NIDEK AFC-230 fundus camera · FOV: 45 degrees · no pharmacologic dilation · graded on the modified Davis scale:
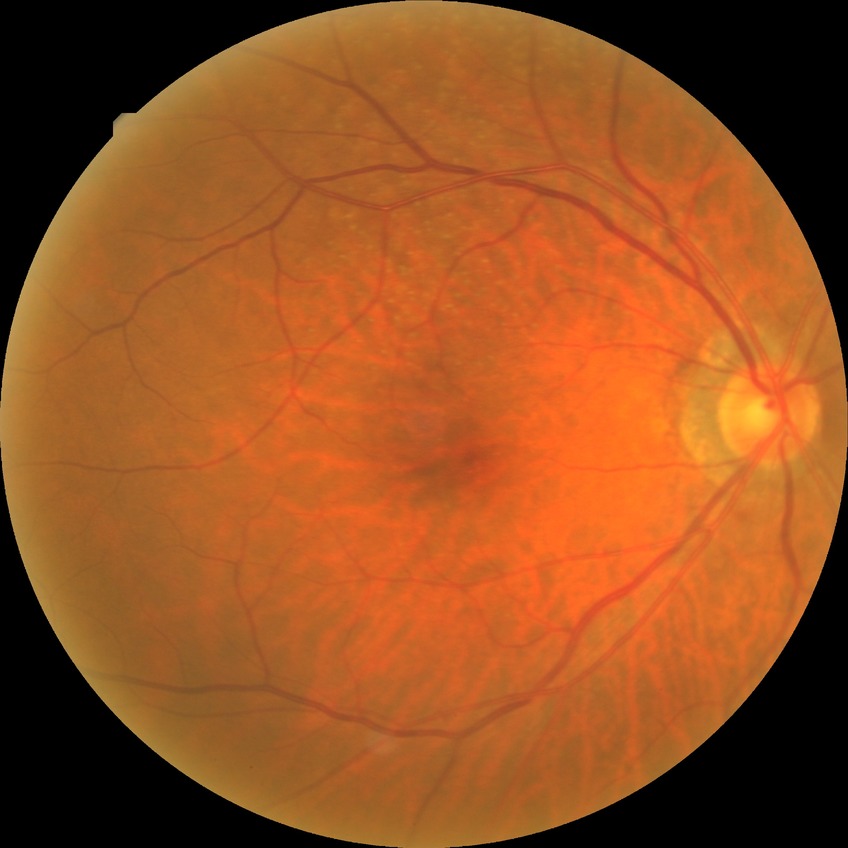

Diabetic retinopathy (DR) is NDR (no diabetic retinopathy).